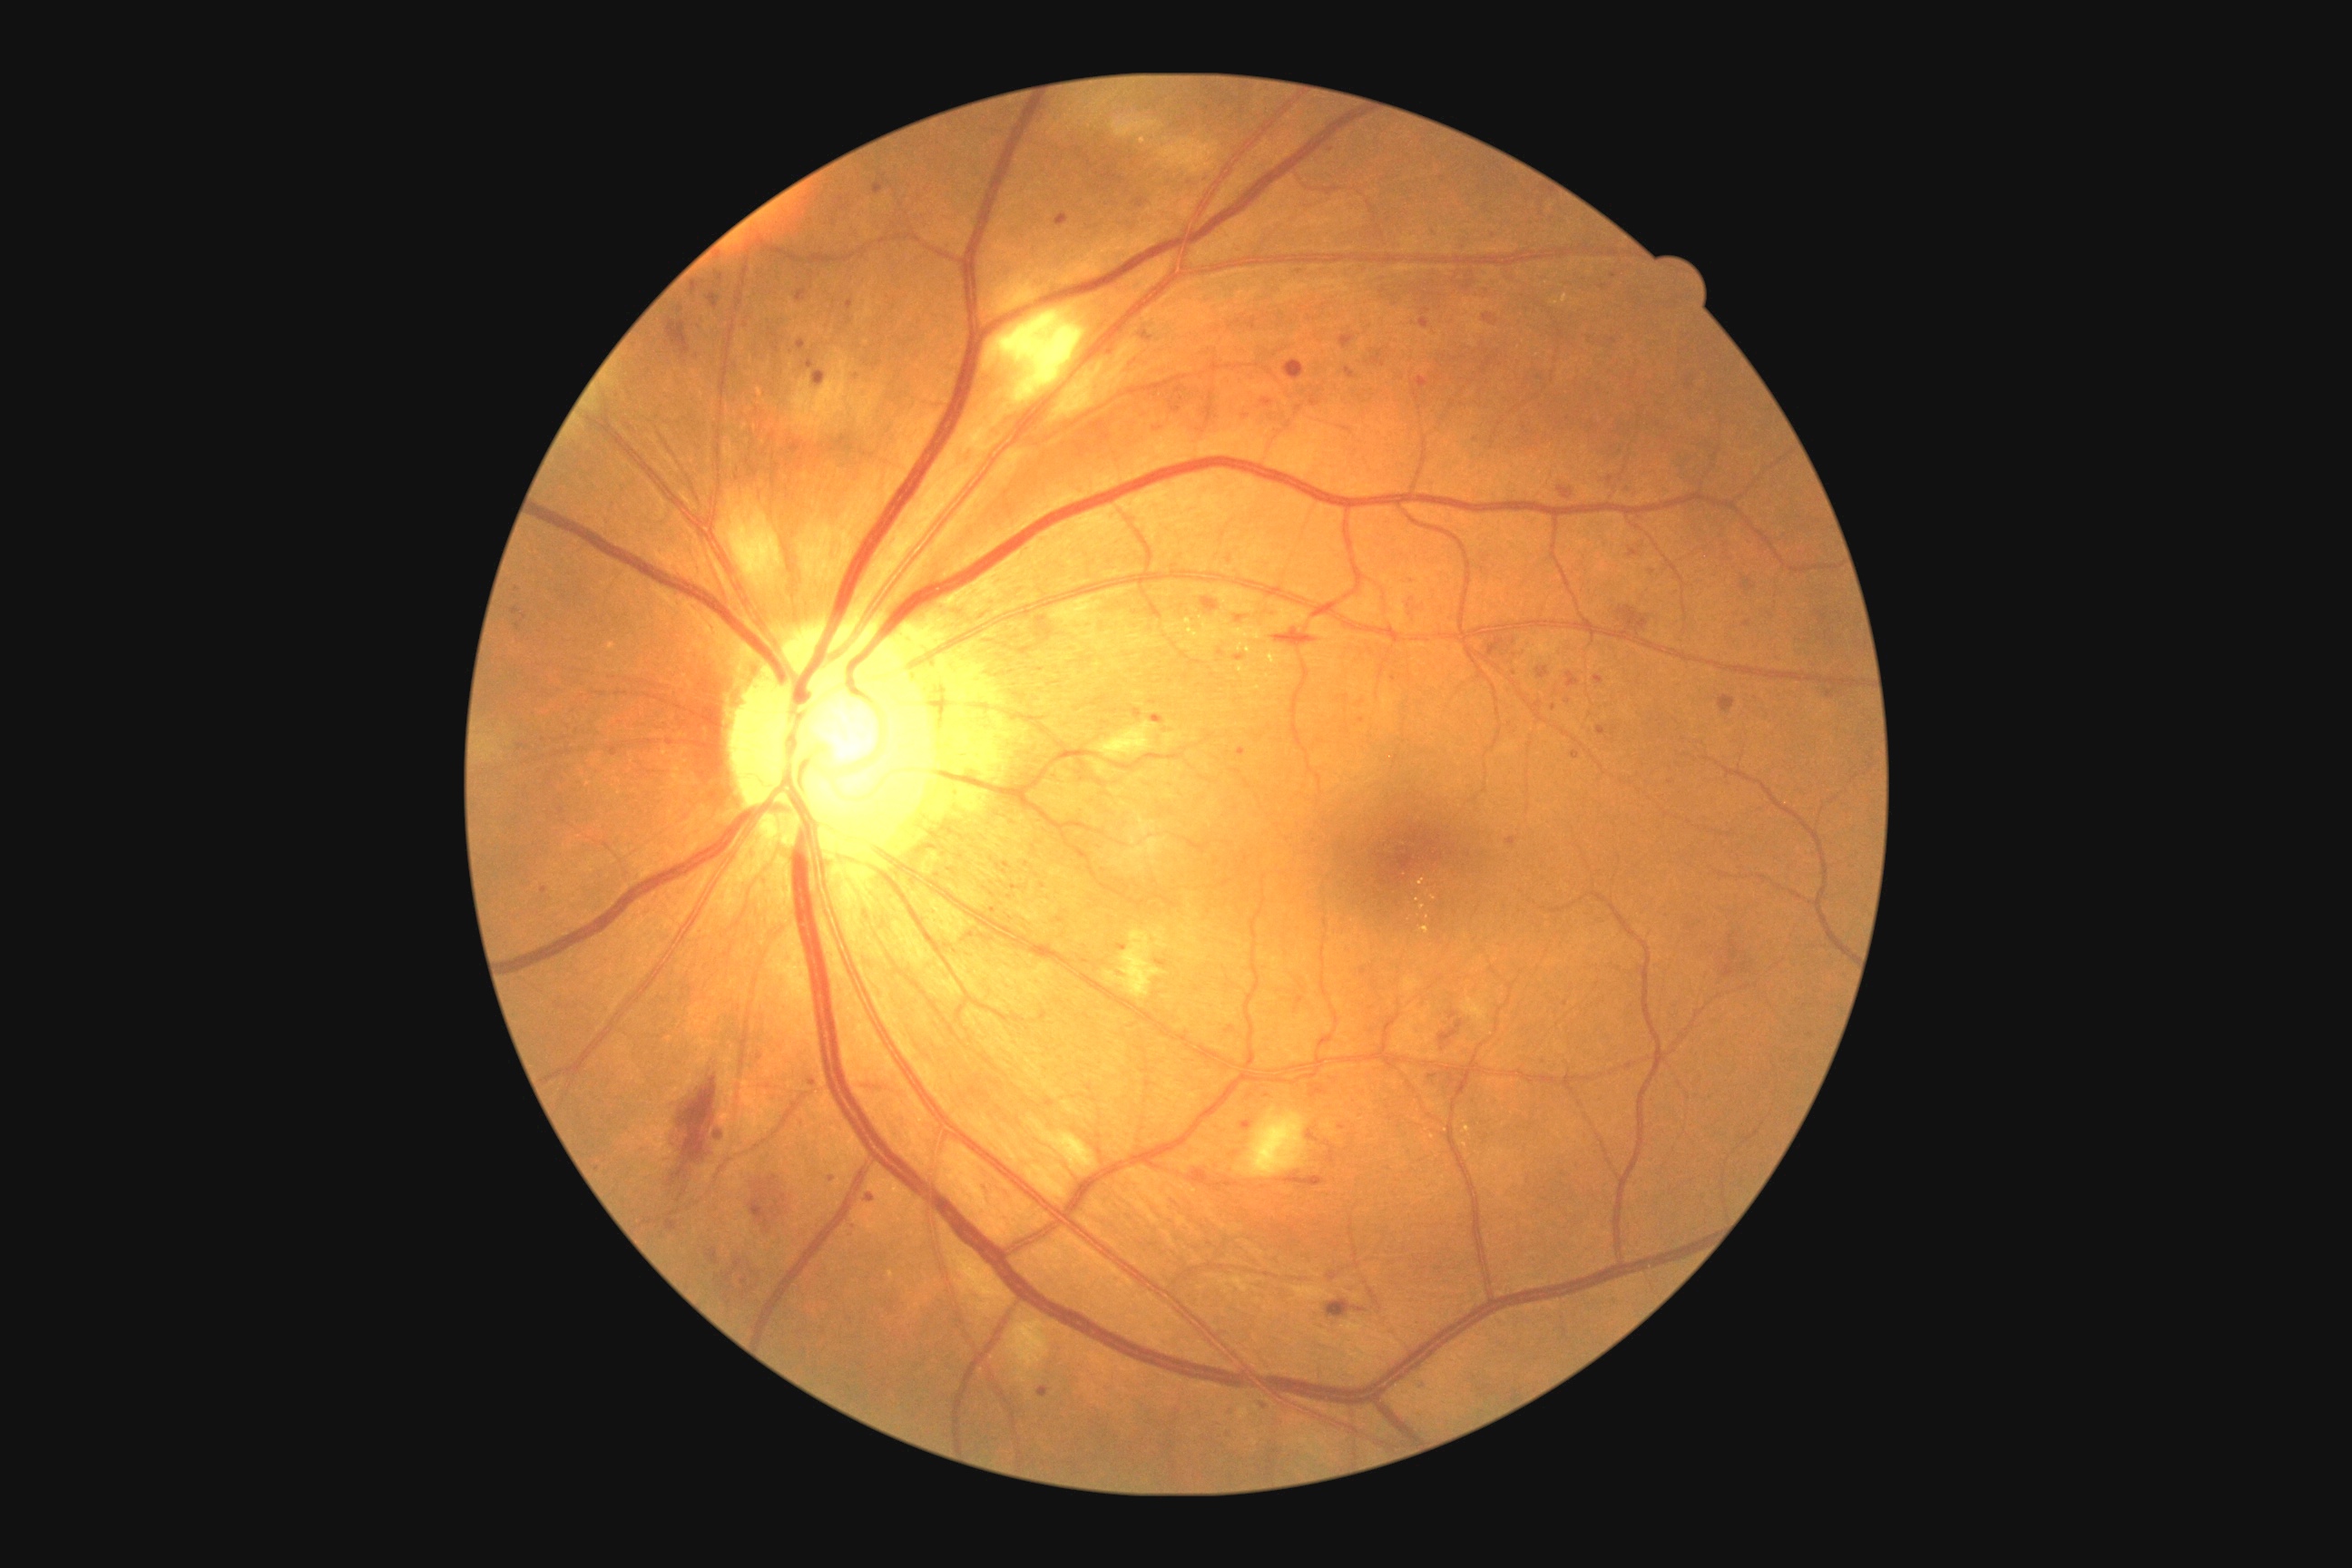

Diabetic retinopathy severity is moderate non-proliferative diabetic retinopathy (grade 2) — more than just microaneurysms but less than severe NPDR; non-proliferative diabetic retinopathy
Selected lesions:
hard exudates (partial): Rect(1239, 663, 1244, 674); Rect(1268, 647, 1291, 665); Rect(1237, 643, 1244, 652); Rect(1231, 627, 1262, 640); Rect(1166, 618, 1226, 647); Rect(1246, 645, 1251, 654); Rect(1562, 295, 1569, 304); Rect(1266, 674, 1279, 687)
Smaller hard exudates around 1555:304; 1253:703; 1256:677; 1257:689
microaneurysms (partial): Rect(1558, 487, 1573, 500); Rect(1269, 612, 1280, 620); Rect(1308, 1130, 1318, 1142); Rect(1629, 547, 1640, 558); Rect(691, 280, 705, 295); Rect(1451, 1012, 1458, 1021); Rect(1596, 727, 1607, 736); Rect(1190, 1170, 1240, 1191); Rect(1482, 315, 1498, 328); Rect(741, 1279, 749, 1286); Rect(1418, 1380, 1427, 1389); Rect(714, 1130, 723, 1141)
Smaller microaneurysms around 1331:150; 1746:624; 1043:887; 1346:699; 993:911; 1613:276; 680:309; 1363:703
hemorrhages (partial): Rect(1326, 1300, 1351, 1318); Rect(1618, 605, 1649, 632); Rect(1200, 596, 1219, 612); Rect(1440, 1021, 1464, 1044); Rect(1309, 1084, 1328, 1099); Rect(667, 320, 691, 357); Rect(1493, 640, 1518, 667); Rect(1273, 627, 1318, 649); Rect(1716, 934, 1754, 981); Rect(669, 1075, 718, 1188); Rect(749, 1175, 792, 1231); Rect(1284, 360, 1306, 382); Rect(1277, 1173, 1326, 1188); Rect(1720, 696, 1736, 714)
soft exudates: Rect(1161, 139, 1219, 175); Rect(1052, 596, 1112, 652); Rect(1110, 117, 1162, 139); Rect(720, 495, 783, 583); Rect(1026, 1117, 1097, 1177); Rect(1235, 1108, 1308, 1179); Rect(1092, 723, 1157, 760); Rect(943, 1237, 1014, 1317); Rect(988, 308, 1086, 406); Rect(1104, 930, 1164, 999); Rect(792, 360, 848, 429); Rect(1008, 1318, 1050, 1384)